45-degree field of view. 1932x1910px:
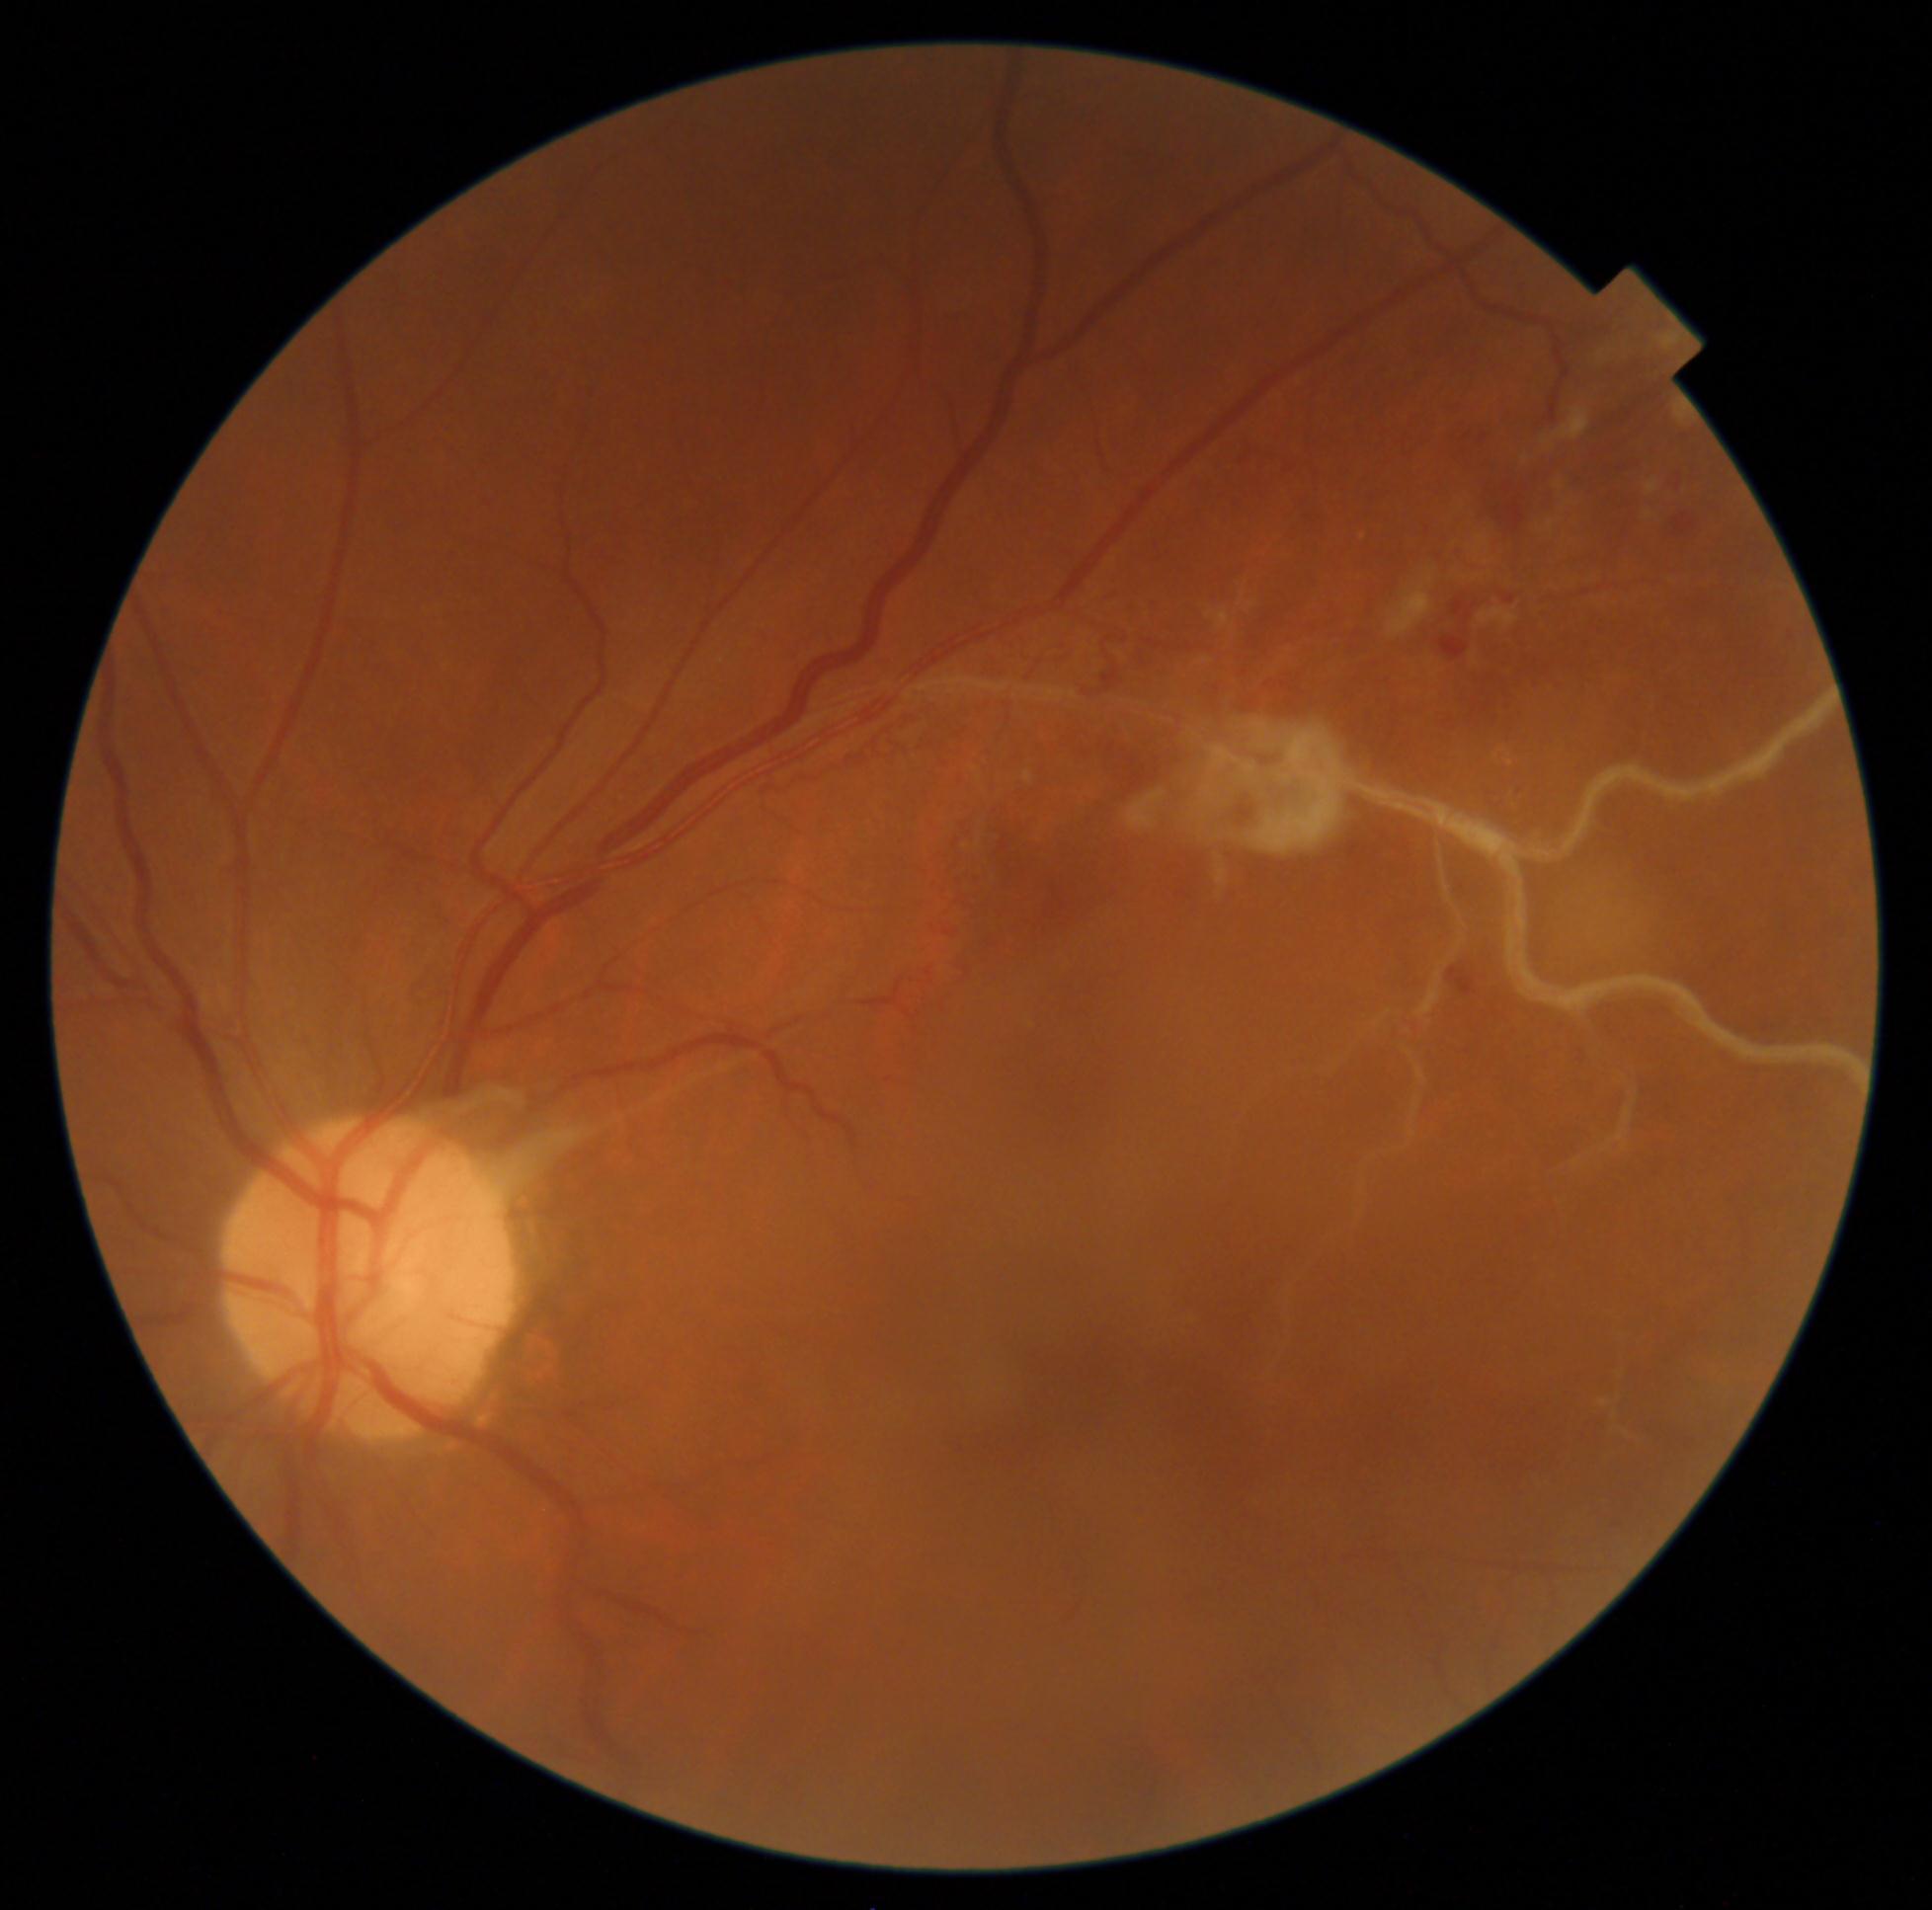

Retinopathy: 2/4.